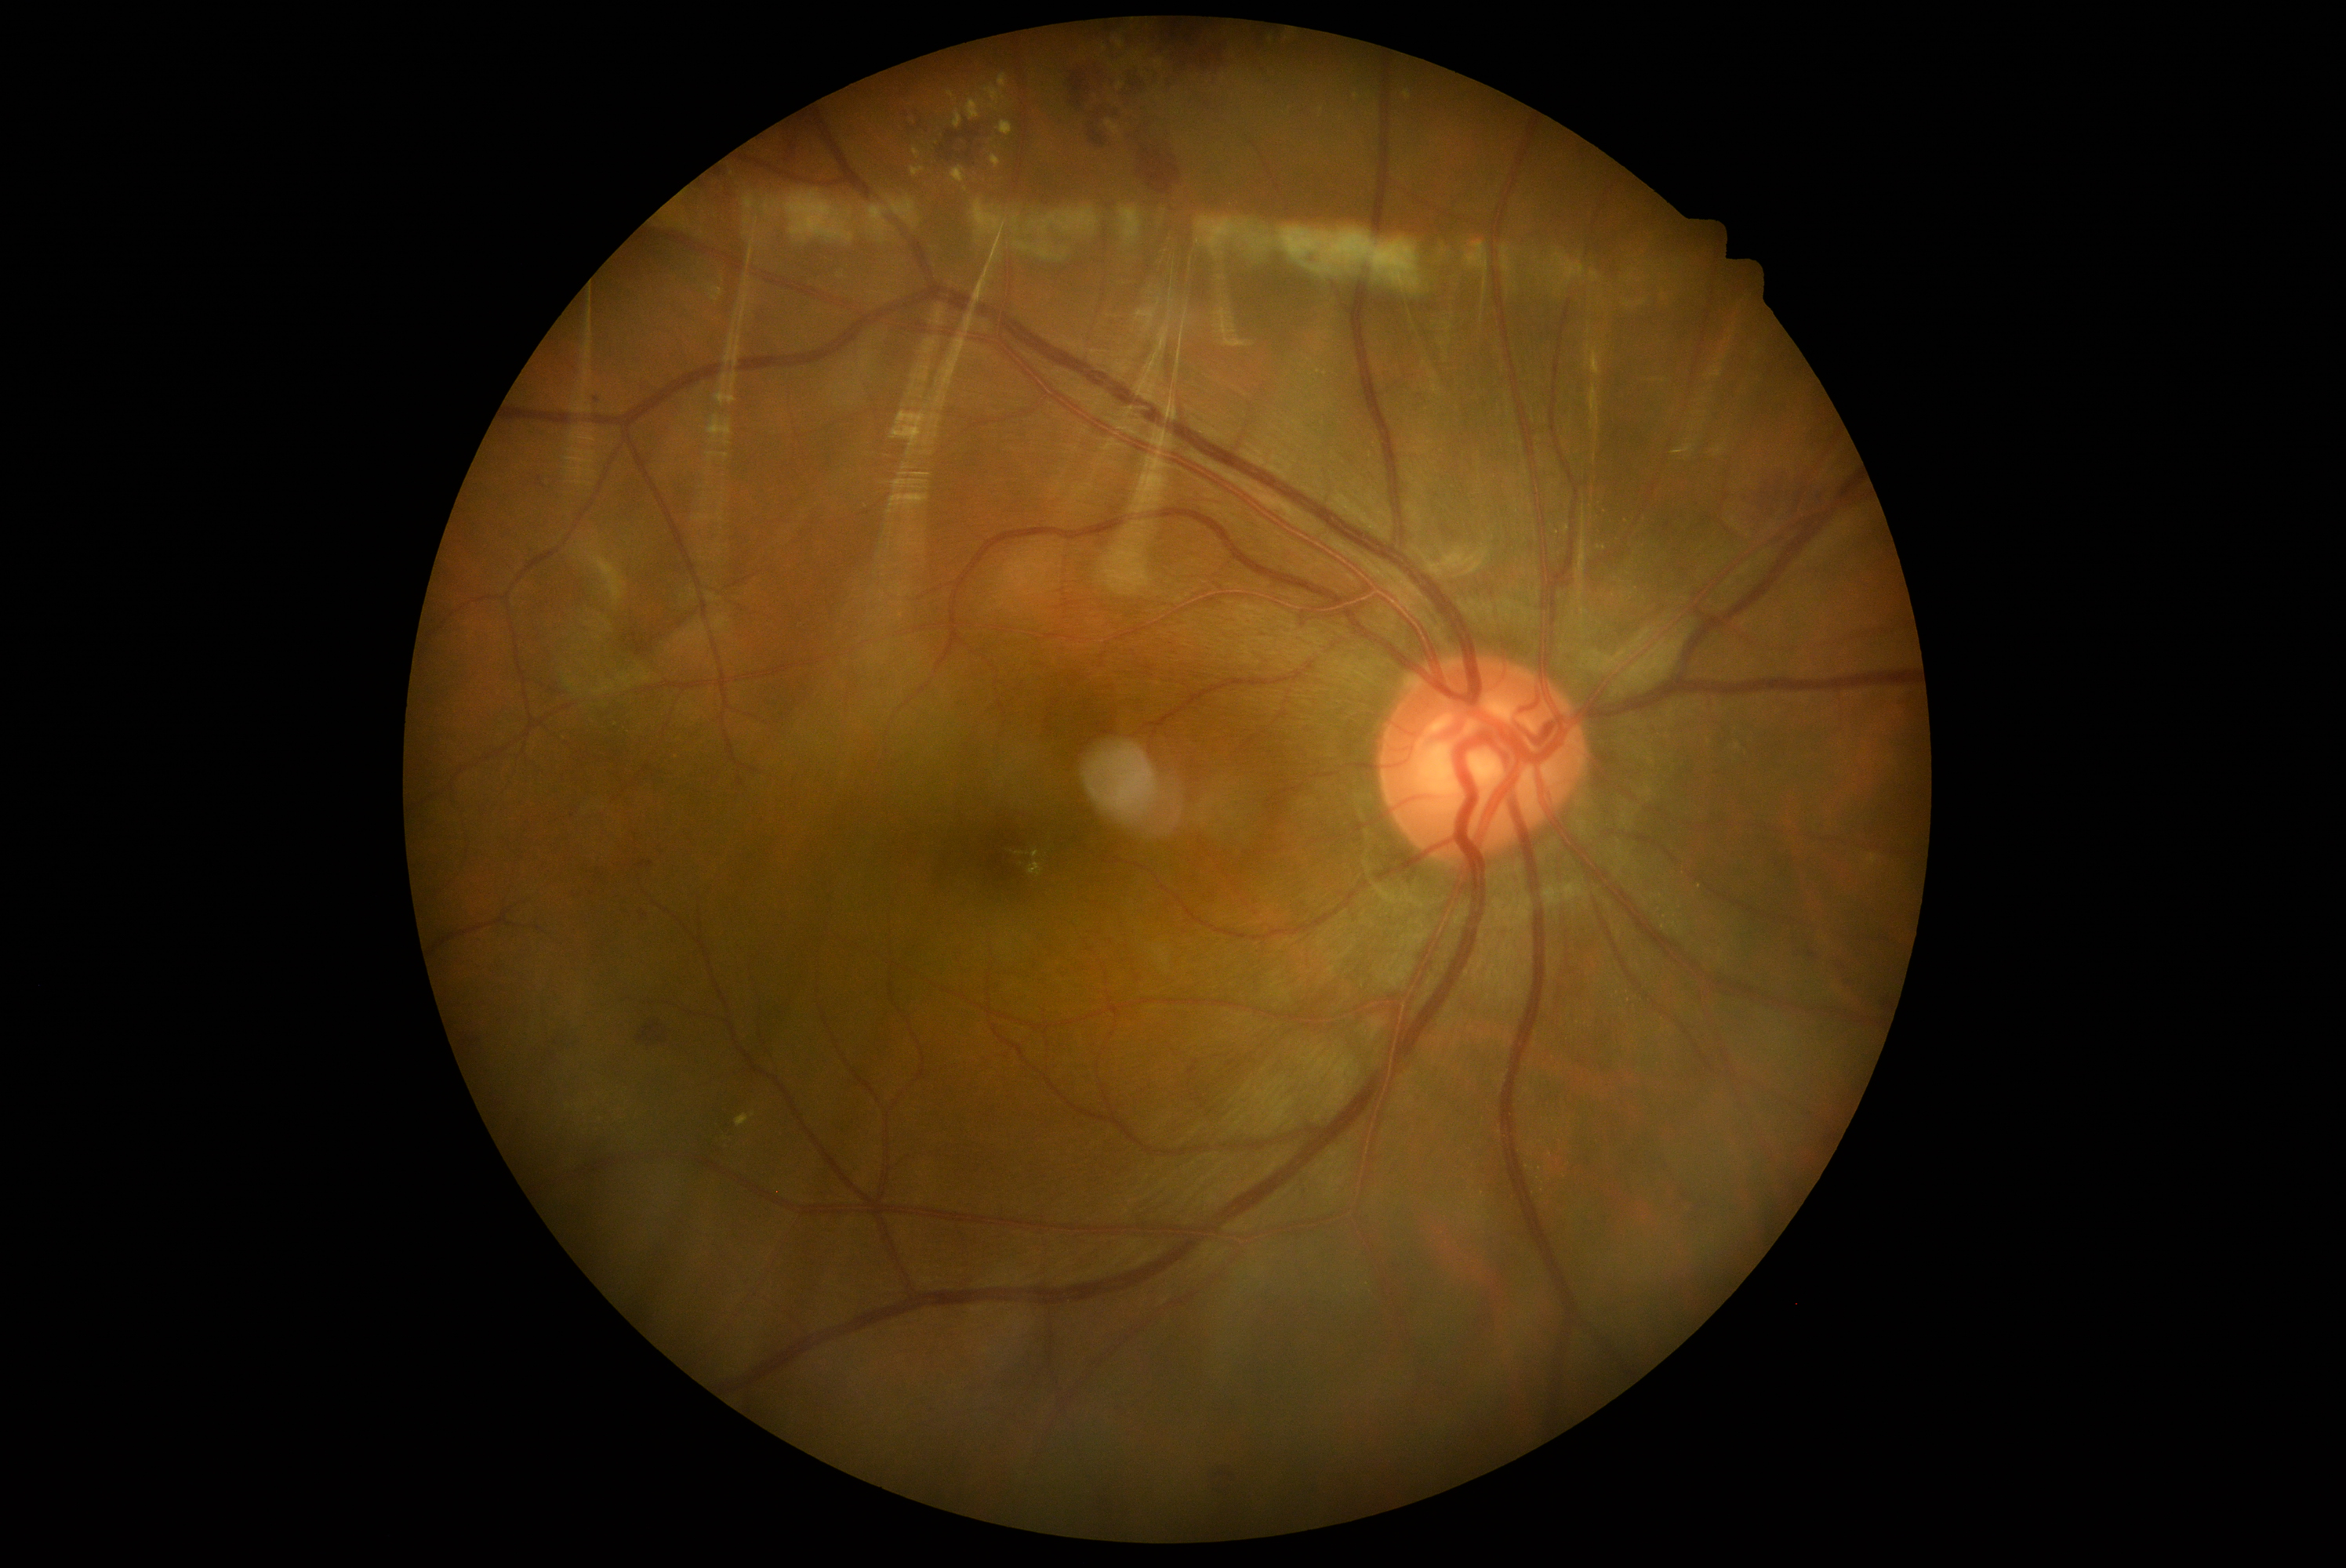 DR: grade 2.